FOV: 45 degrees:
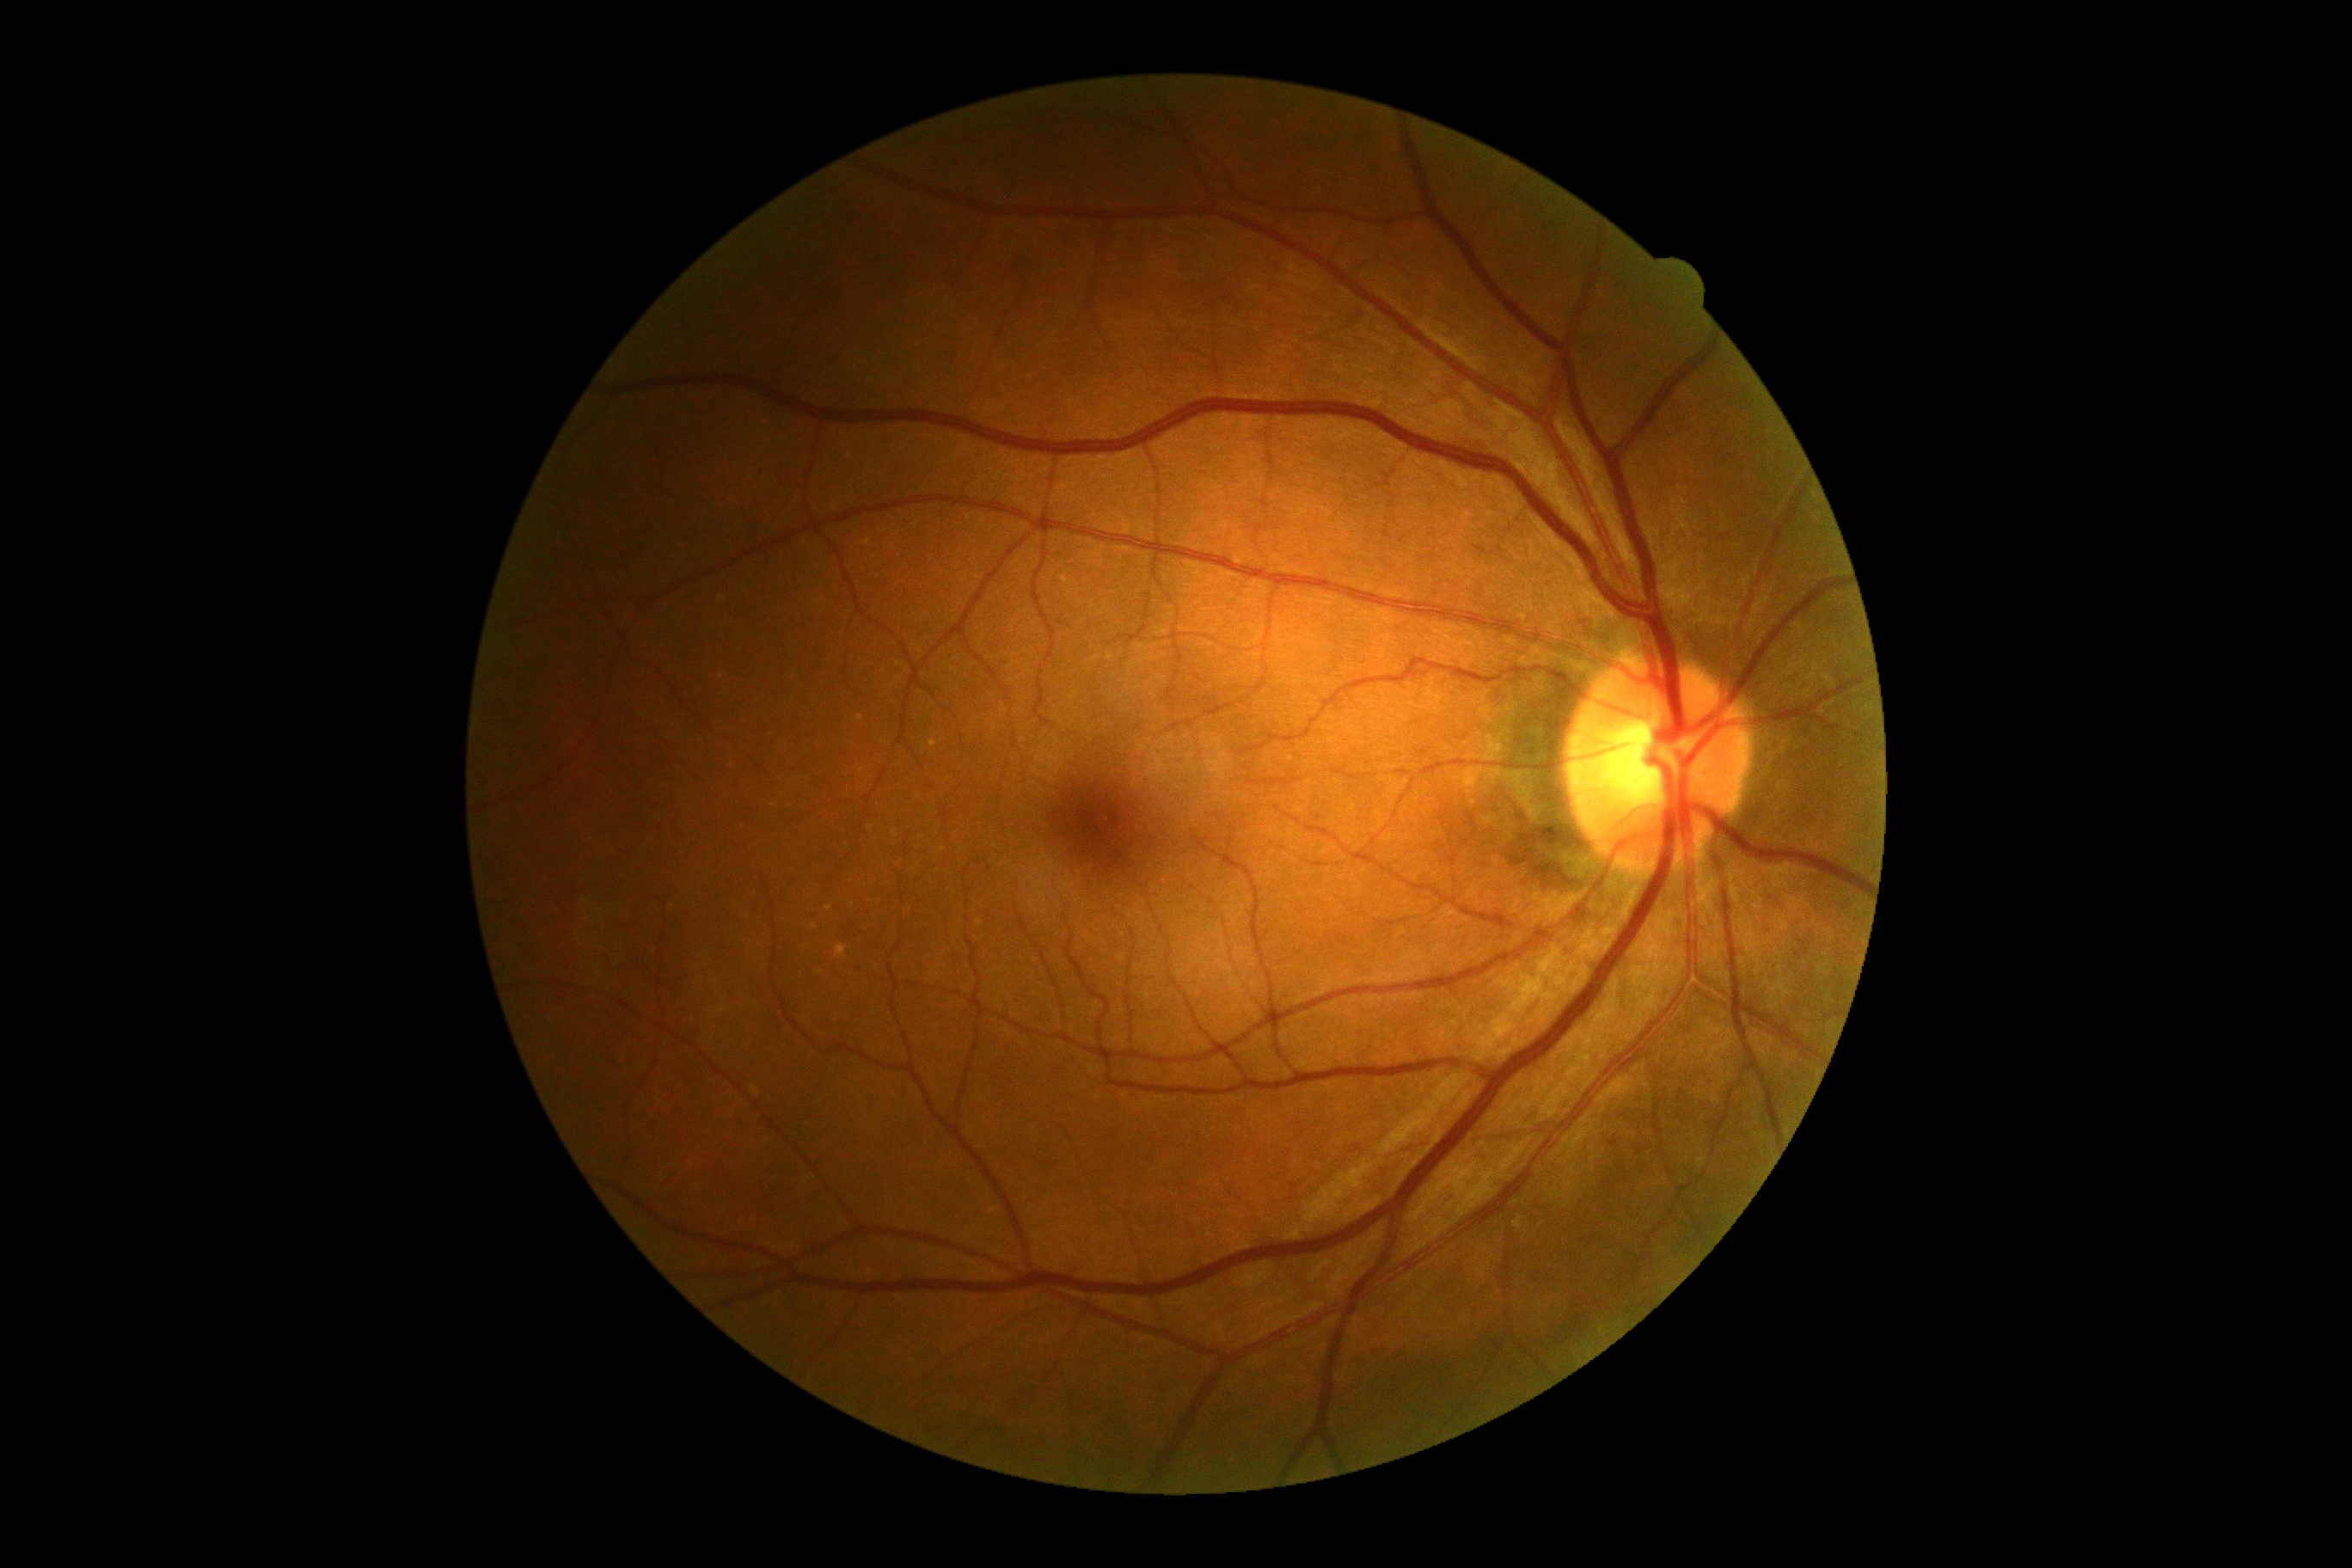

{"dr_grade": "no apparent diabetic retinopathy (grade 0)", "dr_impression": "no apparent DR"}